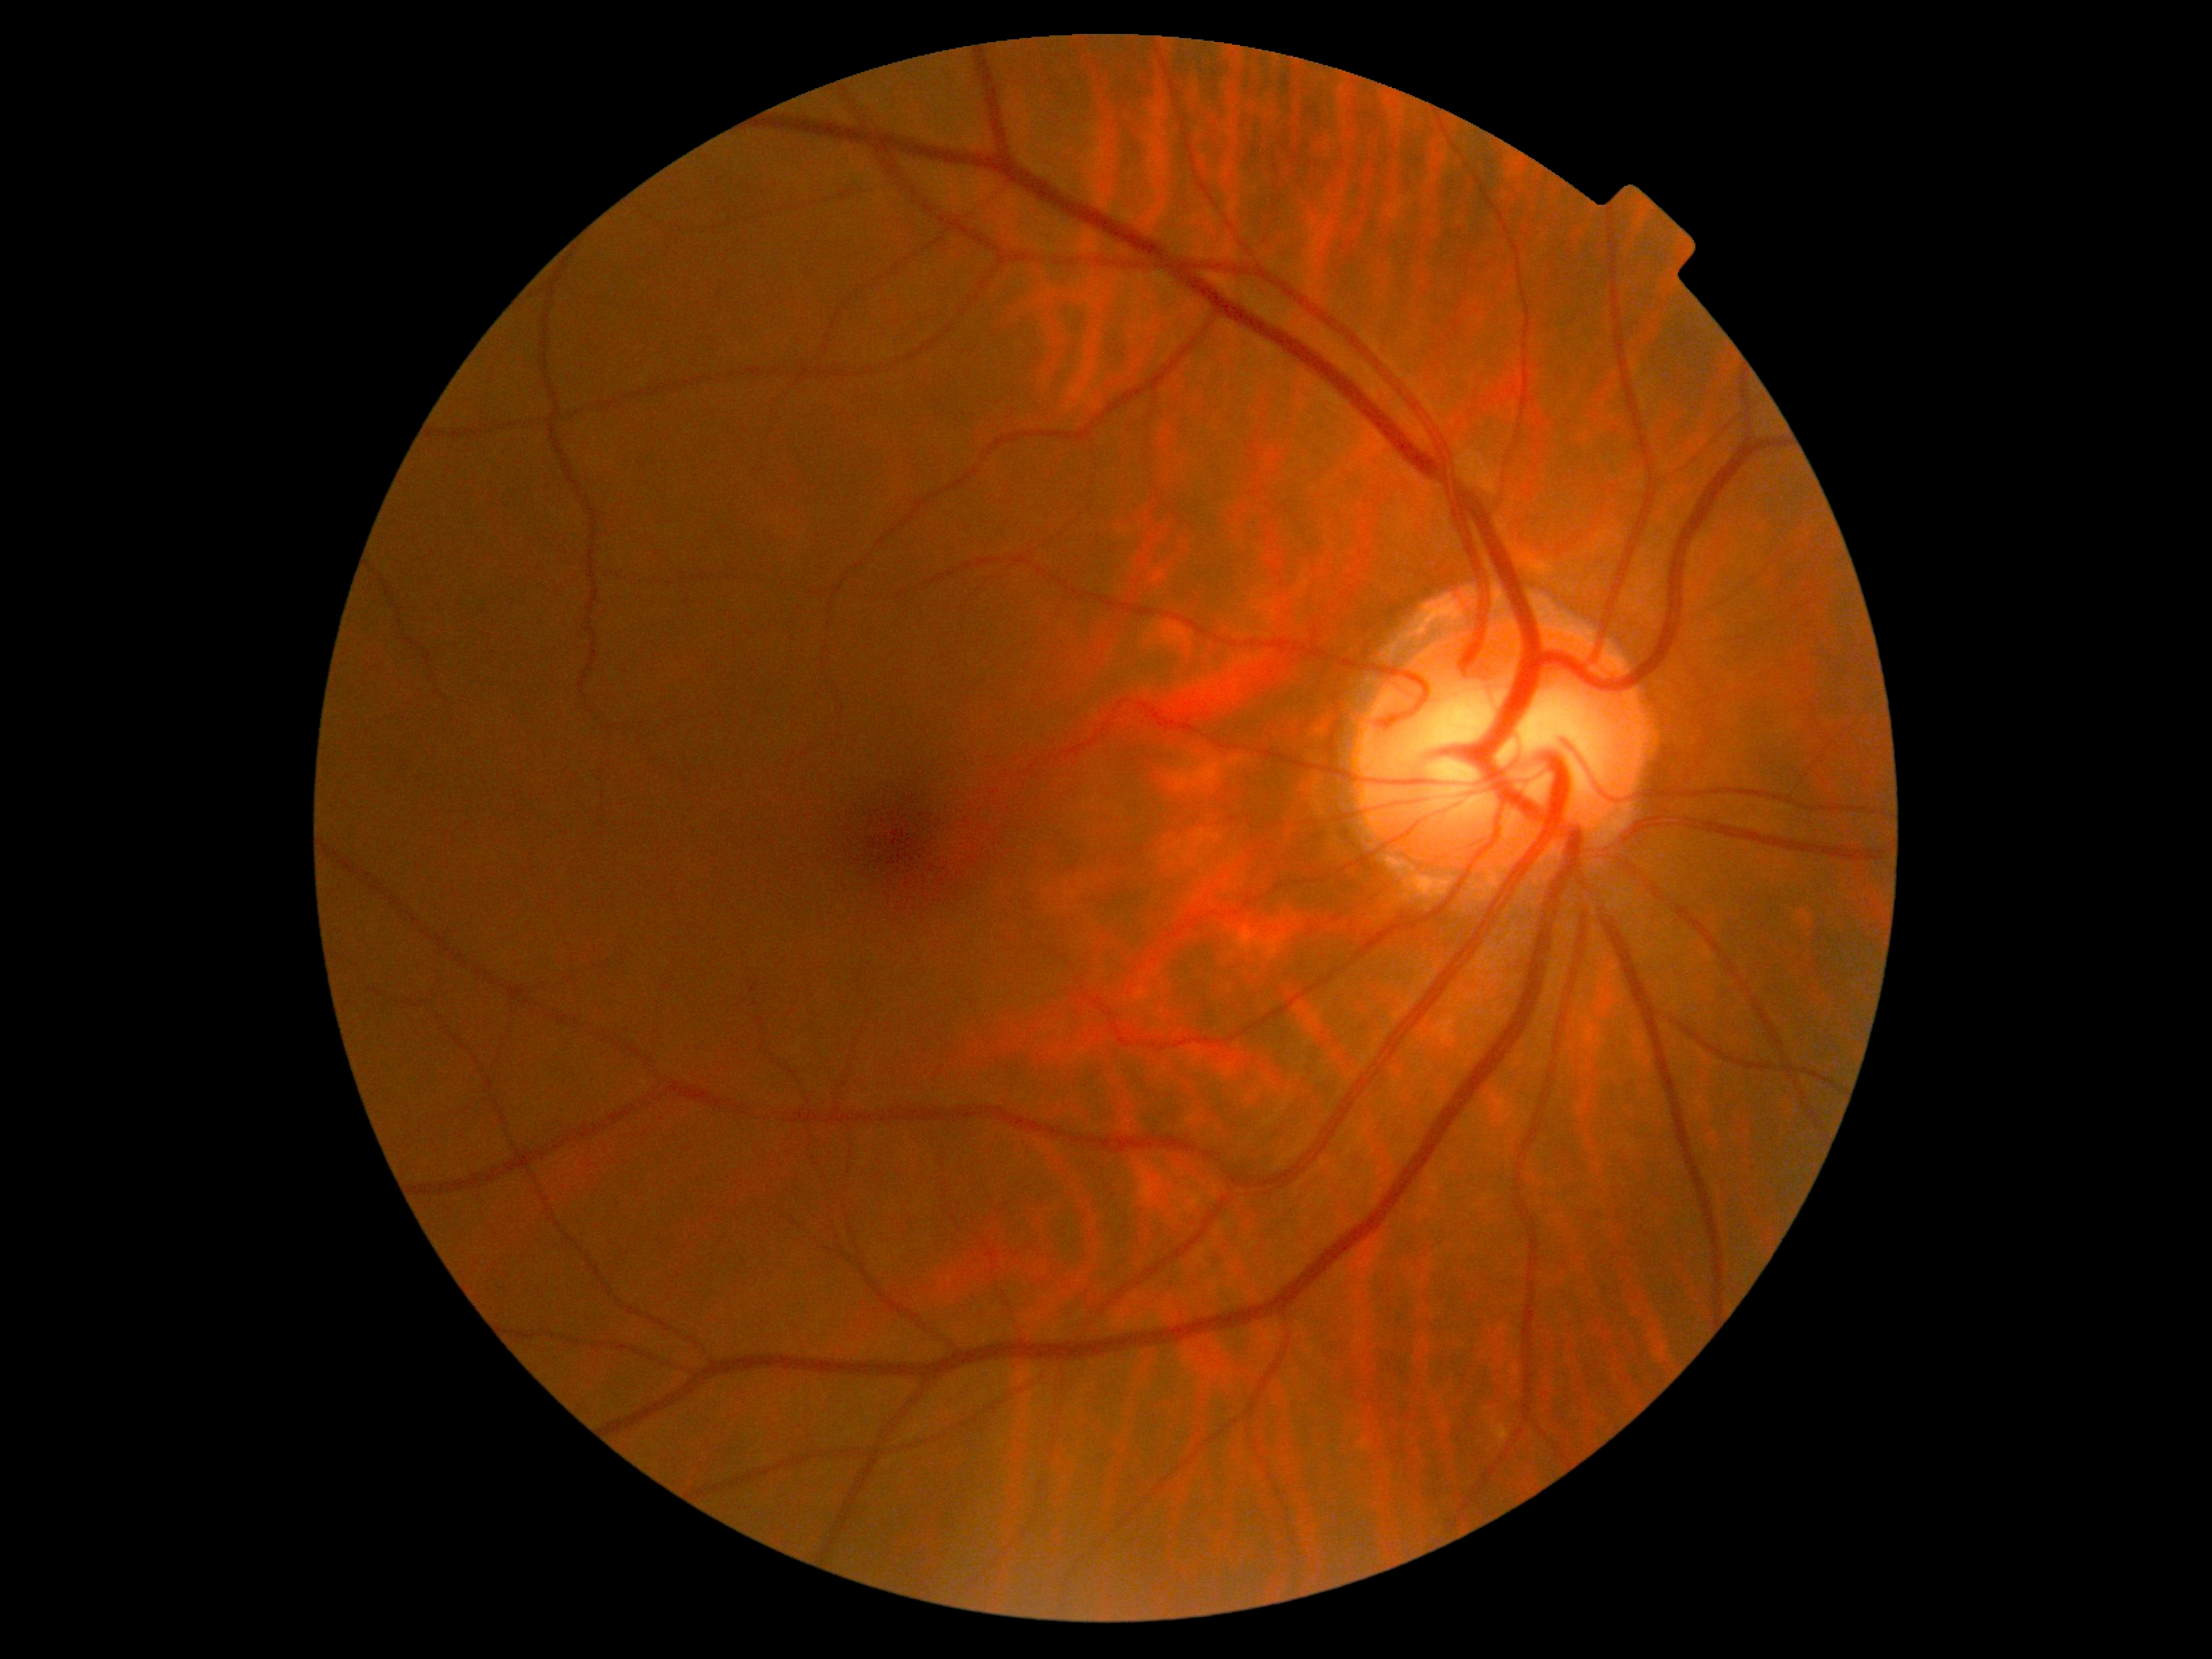
{
  "dr_grade": "no apparent retinopathy (0) — no visible signs of diabetic retinopathy",
  "dr_impression": "no apparent DR"
}